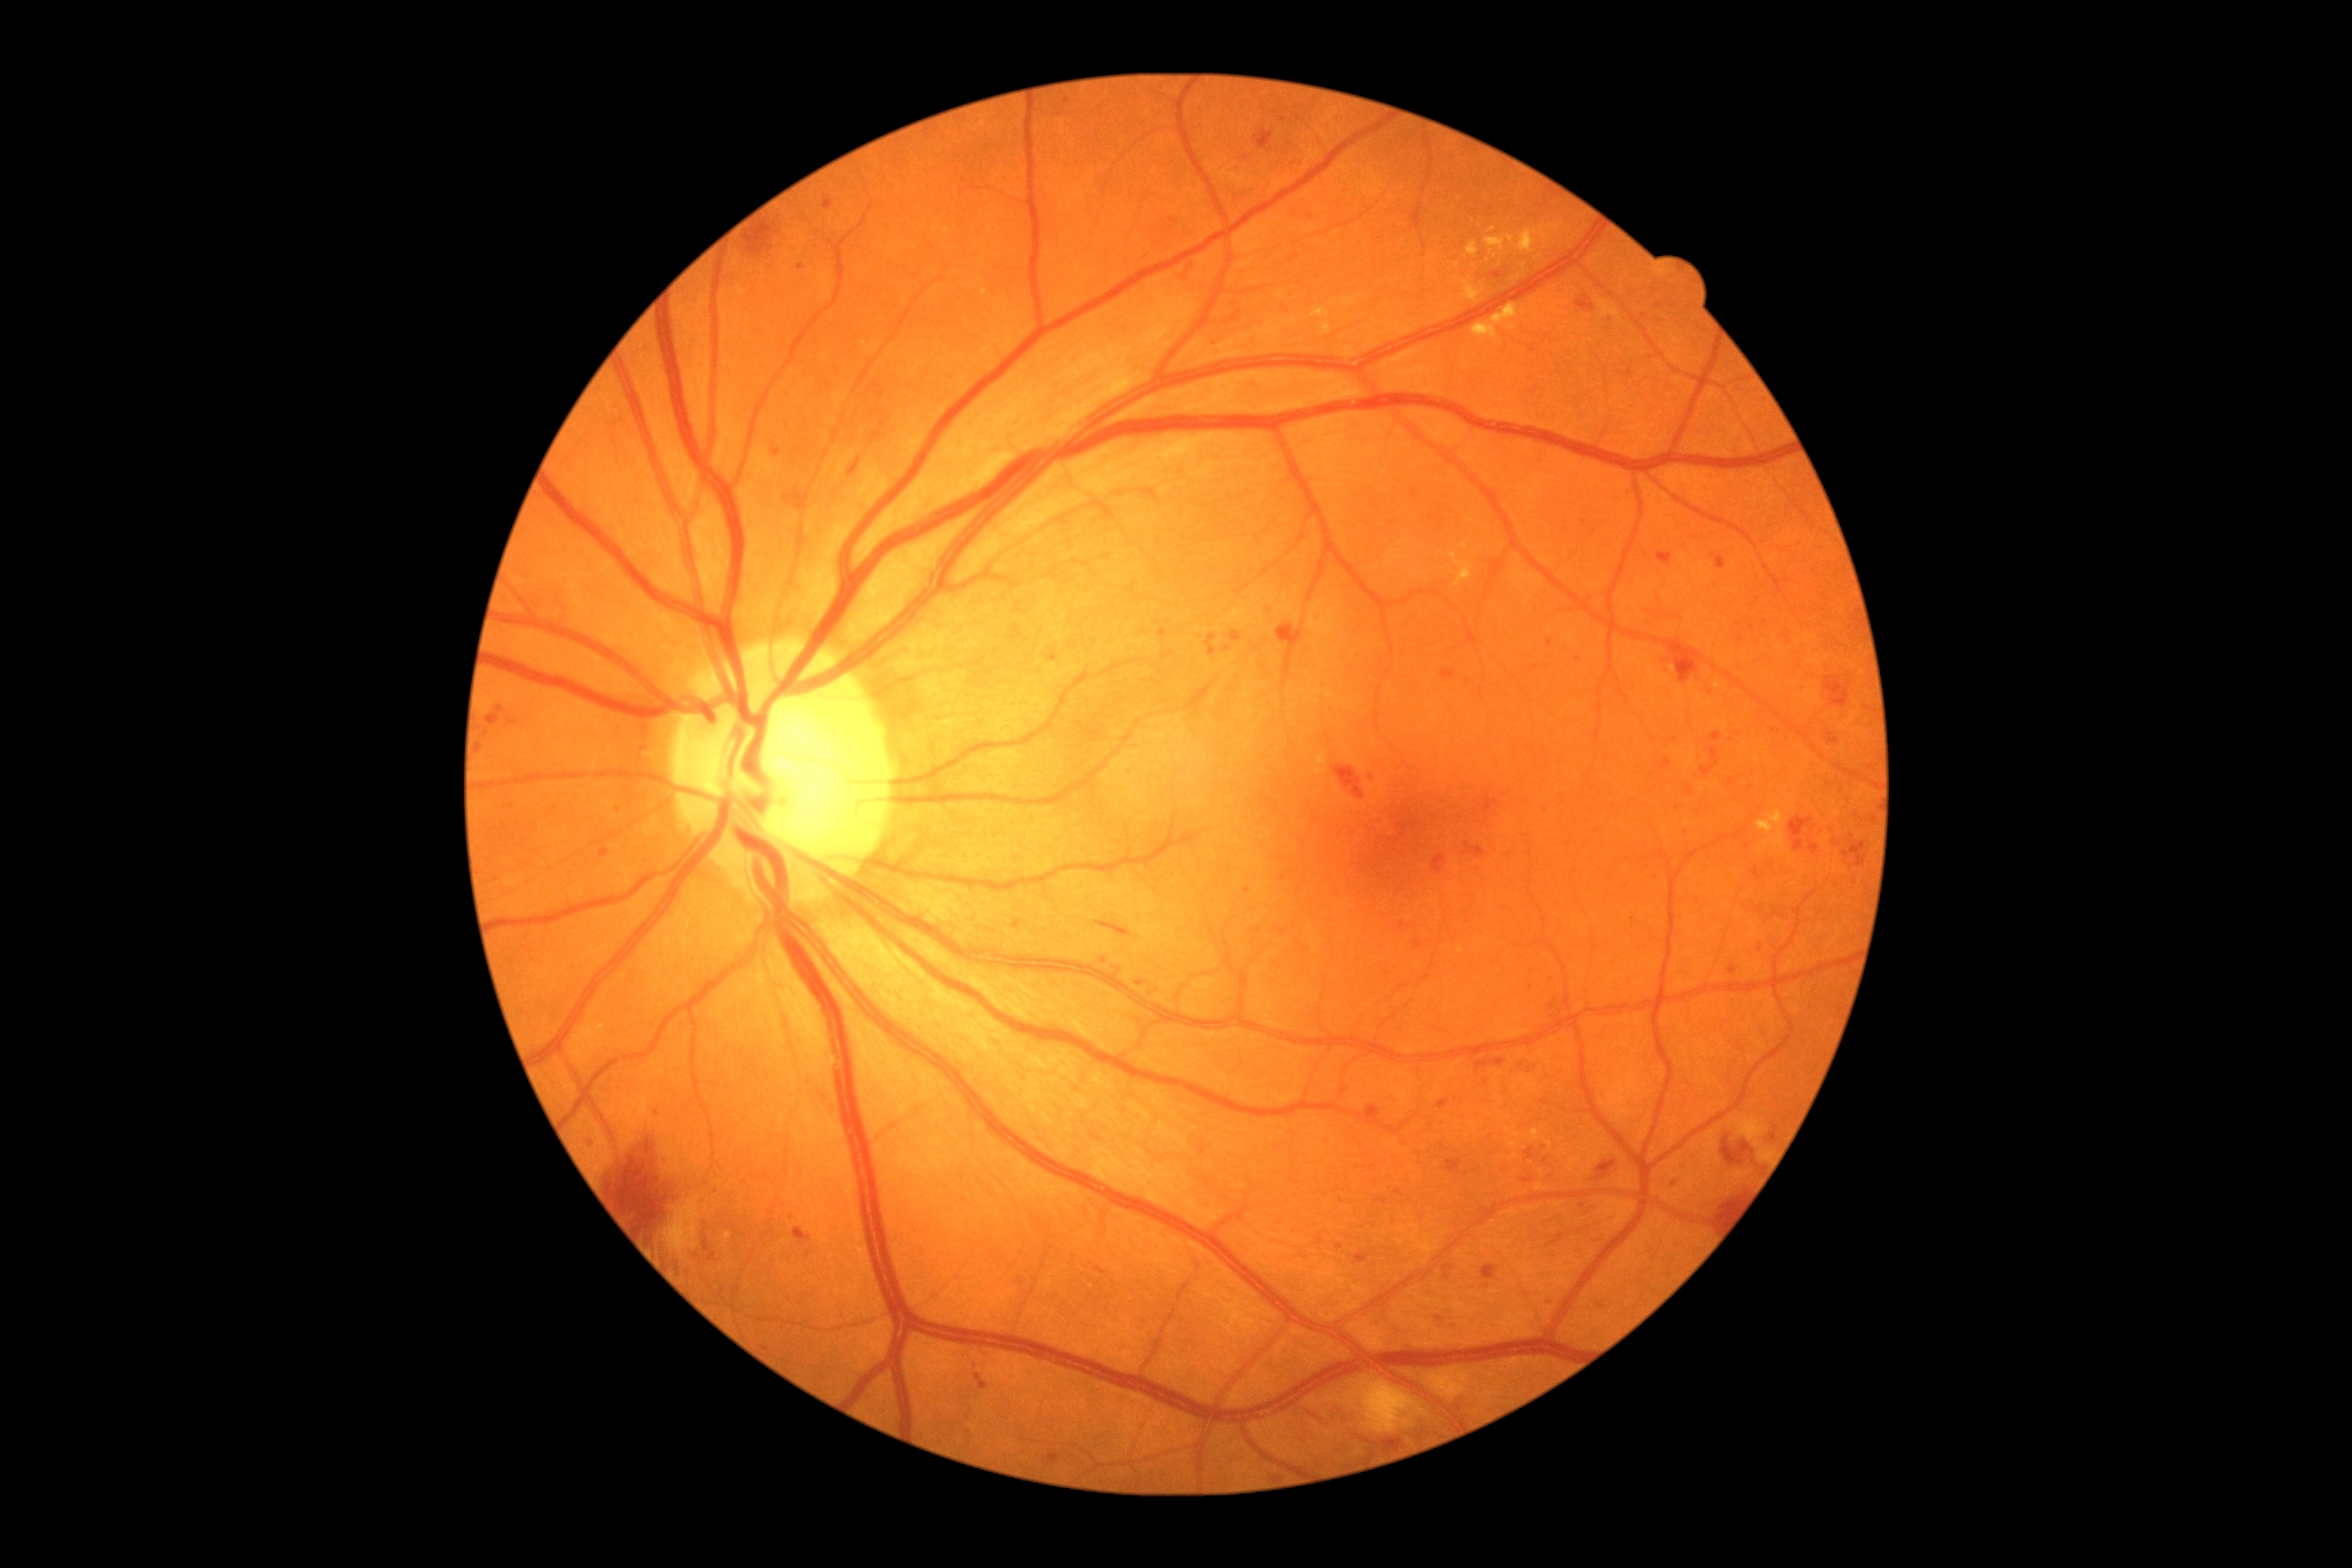
Diabetic retinopathy severity: 2. DR class: non-proliferative diabetic retinopathy.